130° field of view (Clarity RetCam 3) · pediatric retinal photograph (wide-field) · 640 x 480 pixels
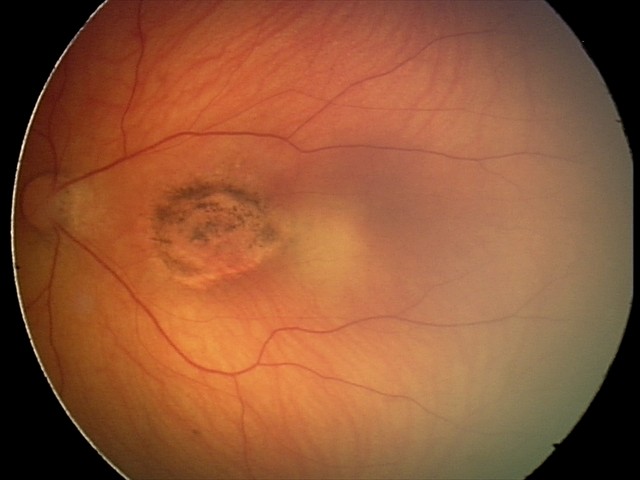 Diagnosis = toxoplasmosis chorioretinitis.